Nonmydriatic; 45° FOV; acquired with a NIDEK AFC-230; 848 x 848 pixels; posterior pole photograph: 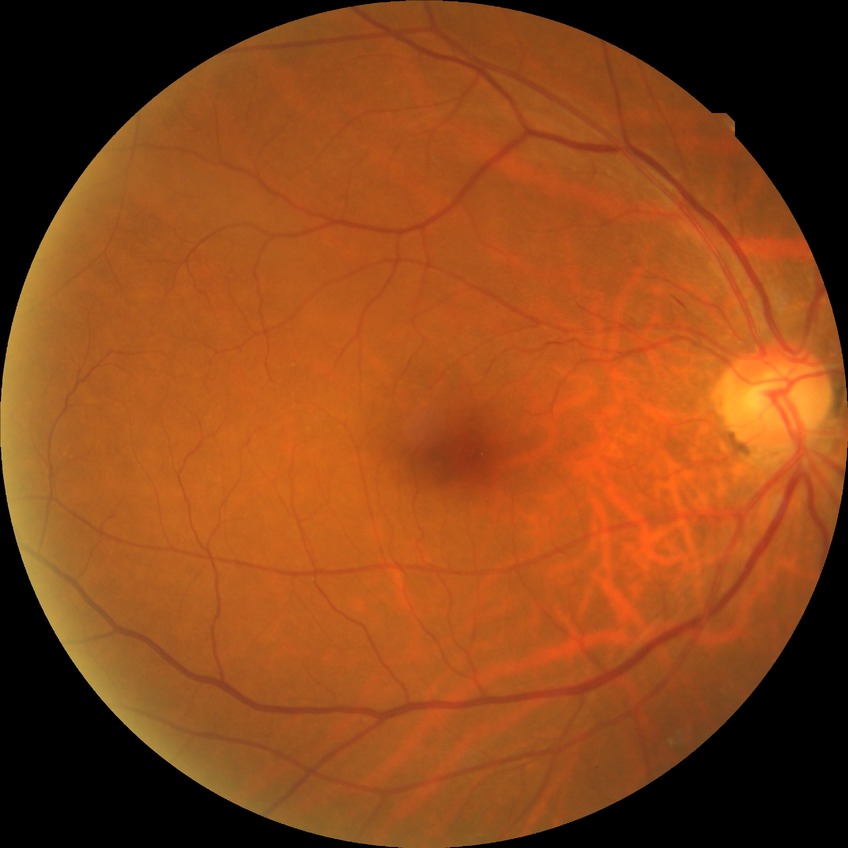   davis_grade: NDR
  dr_impression: negative for DR